Fundus photo taken with a portable handheld camera: 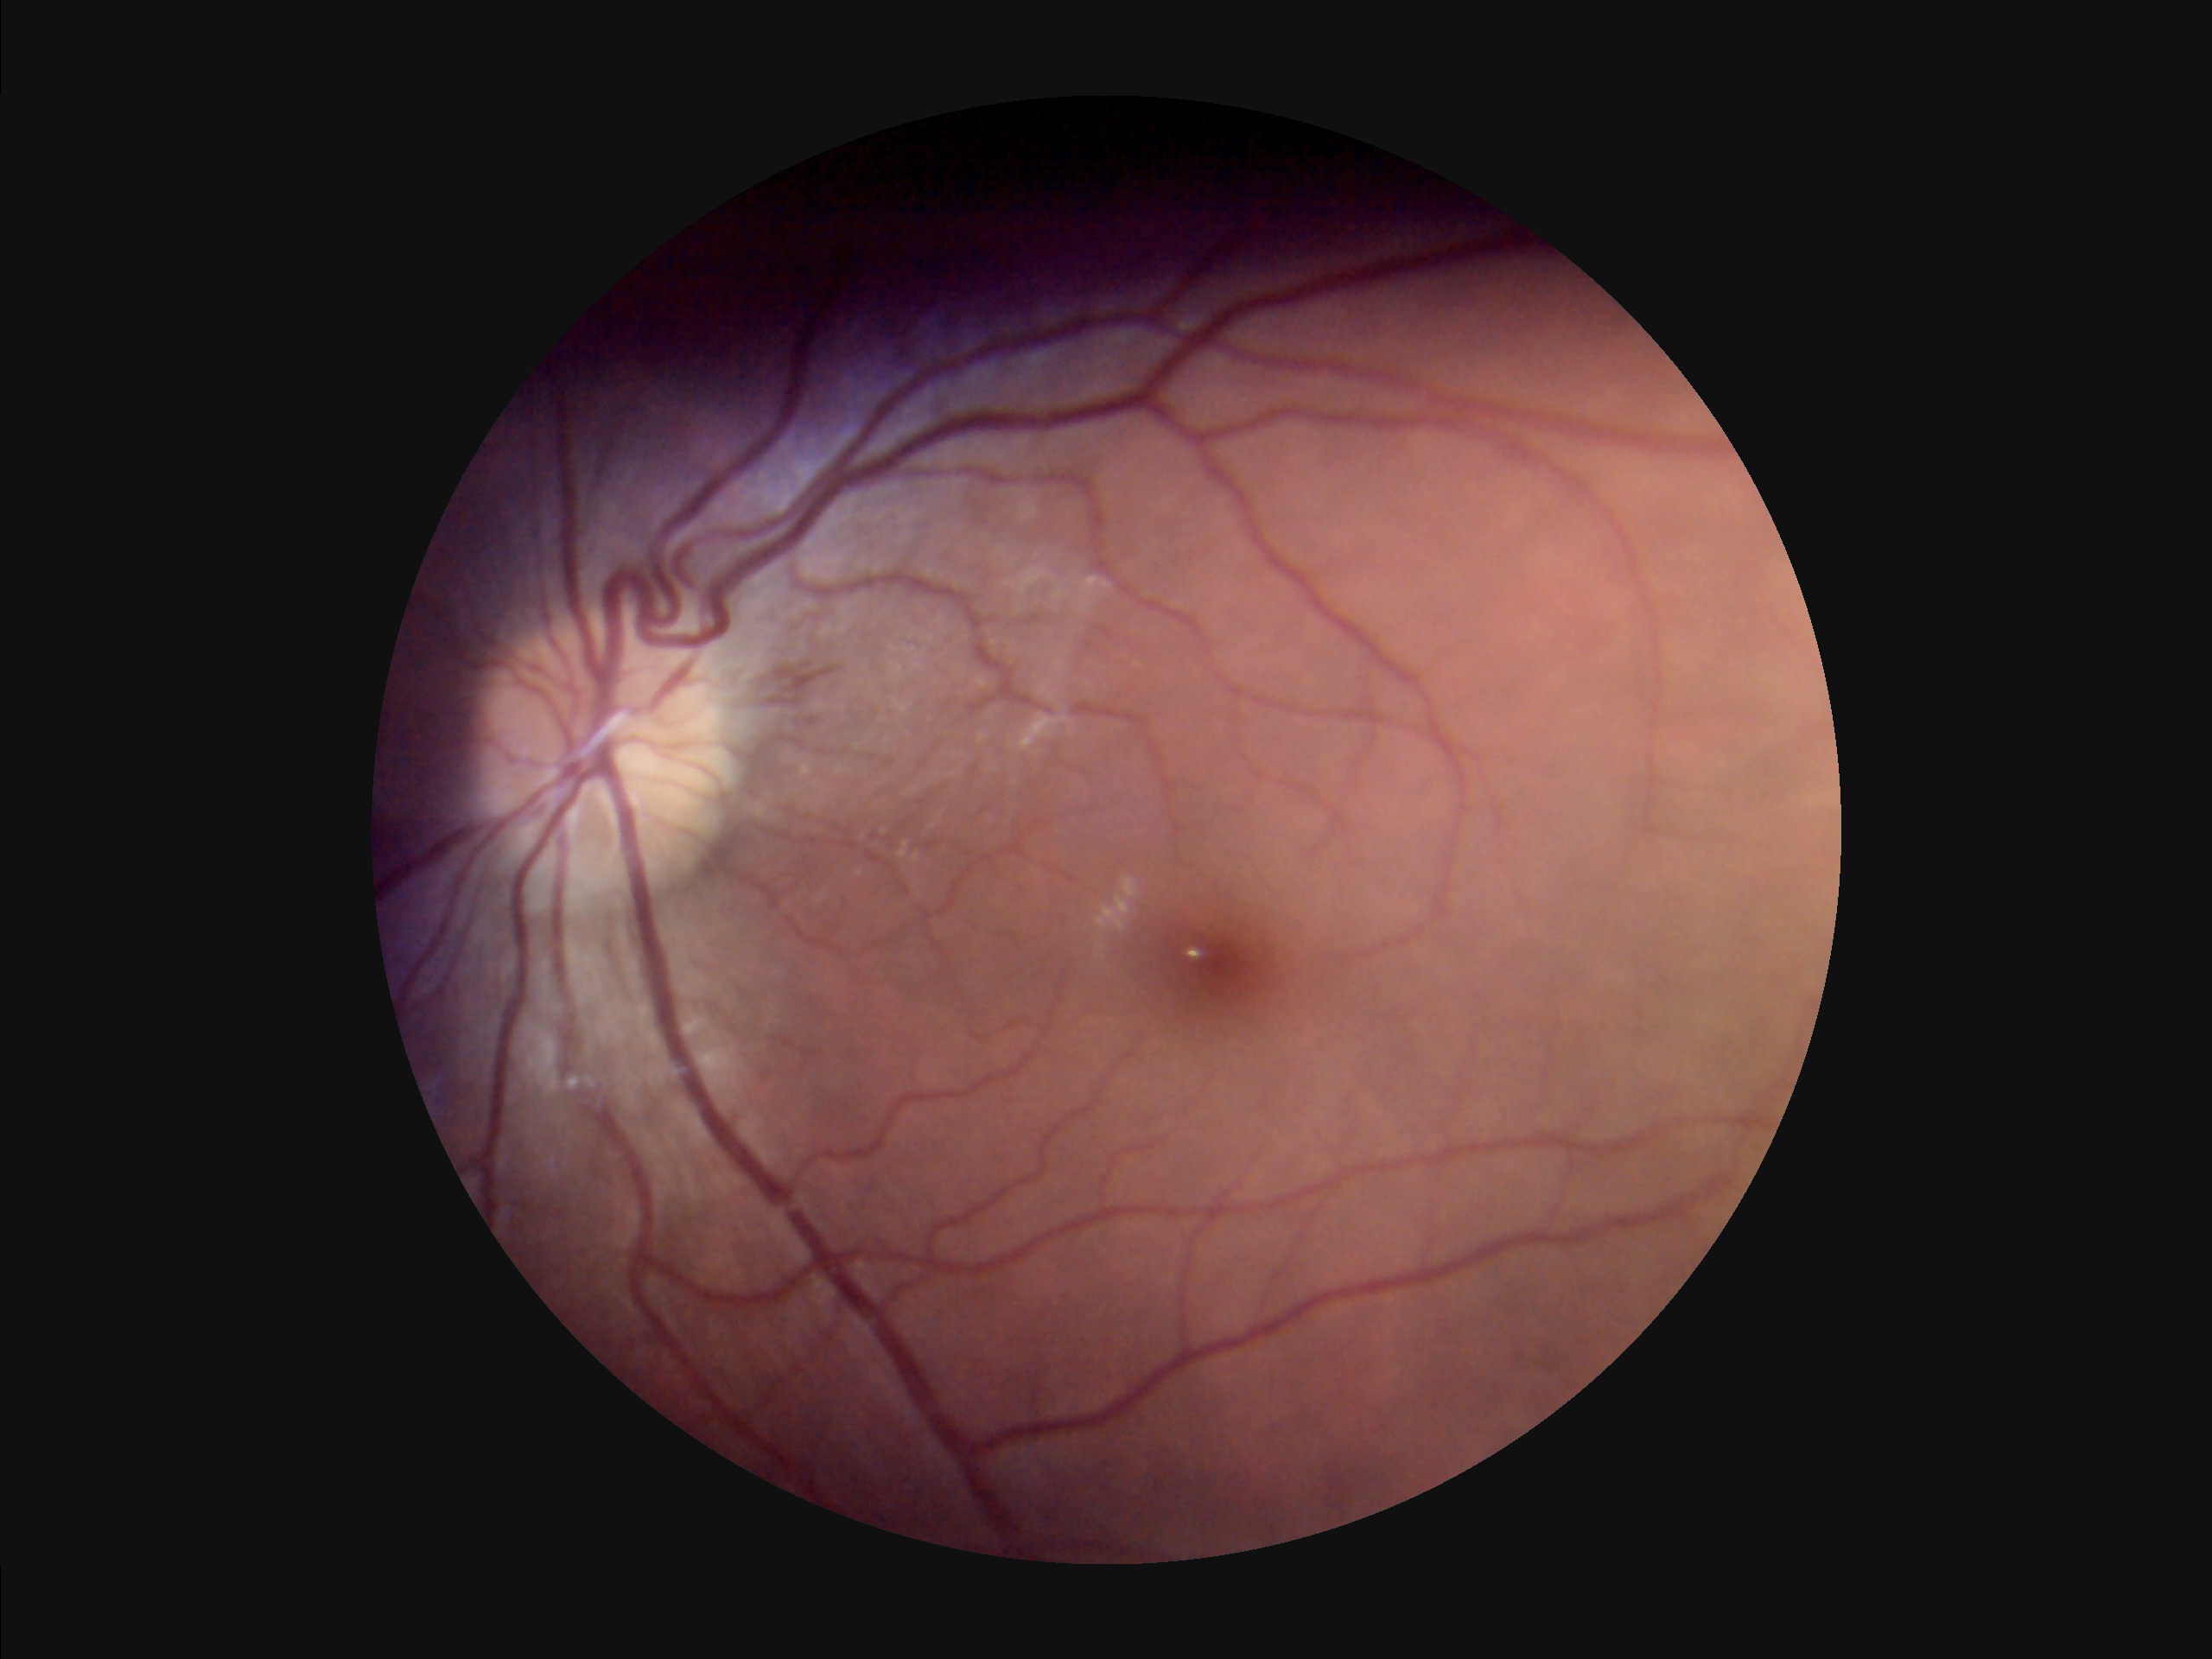

Image quality: contrast: good dynamic range | sharpness: optic disc, vessels, and background in focus | illumination/color: uneven illumination or color cast | overall: poor, ungradable.